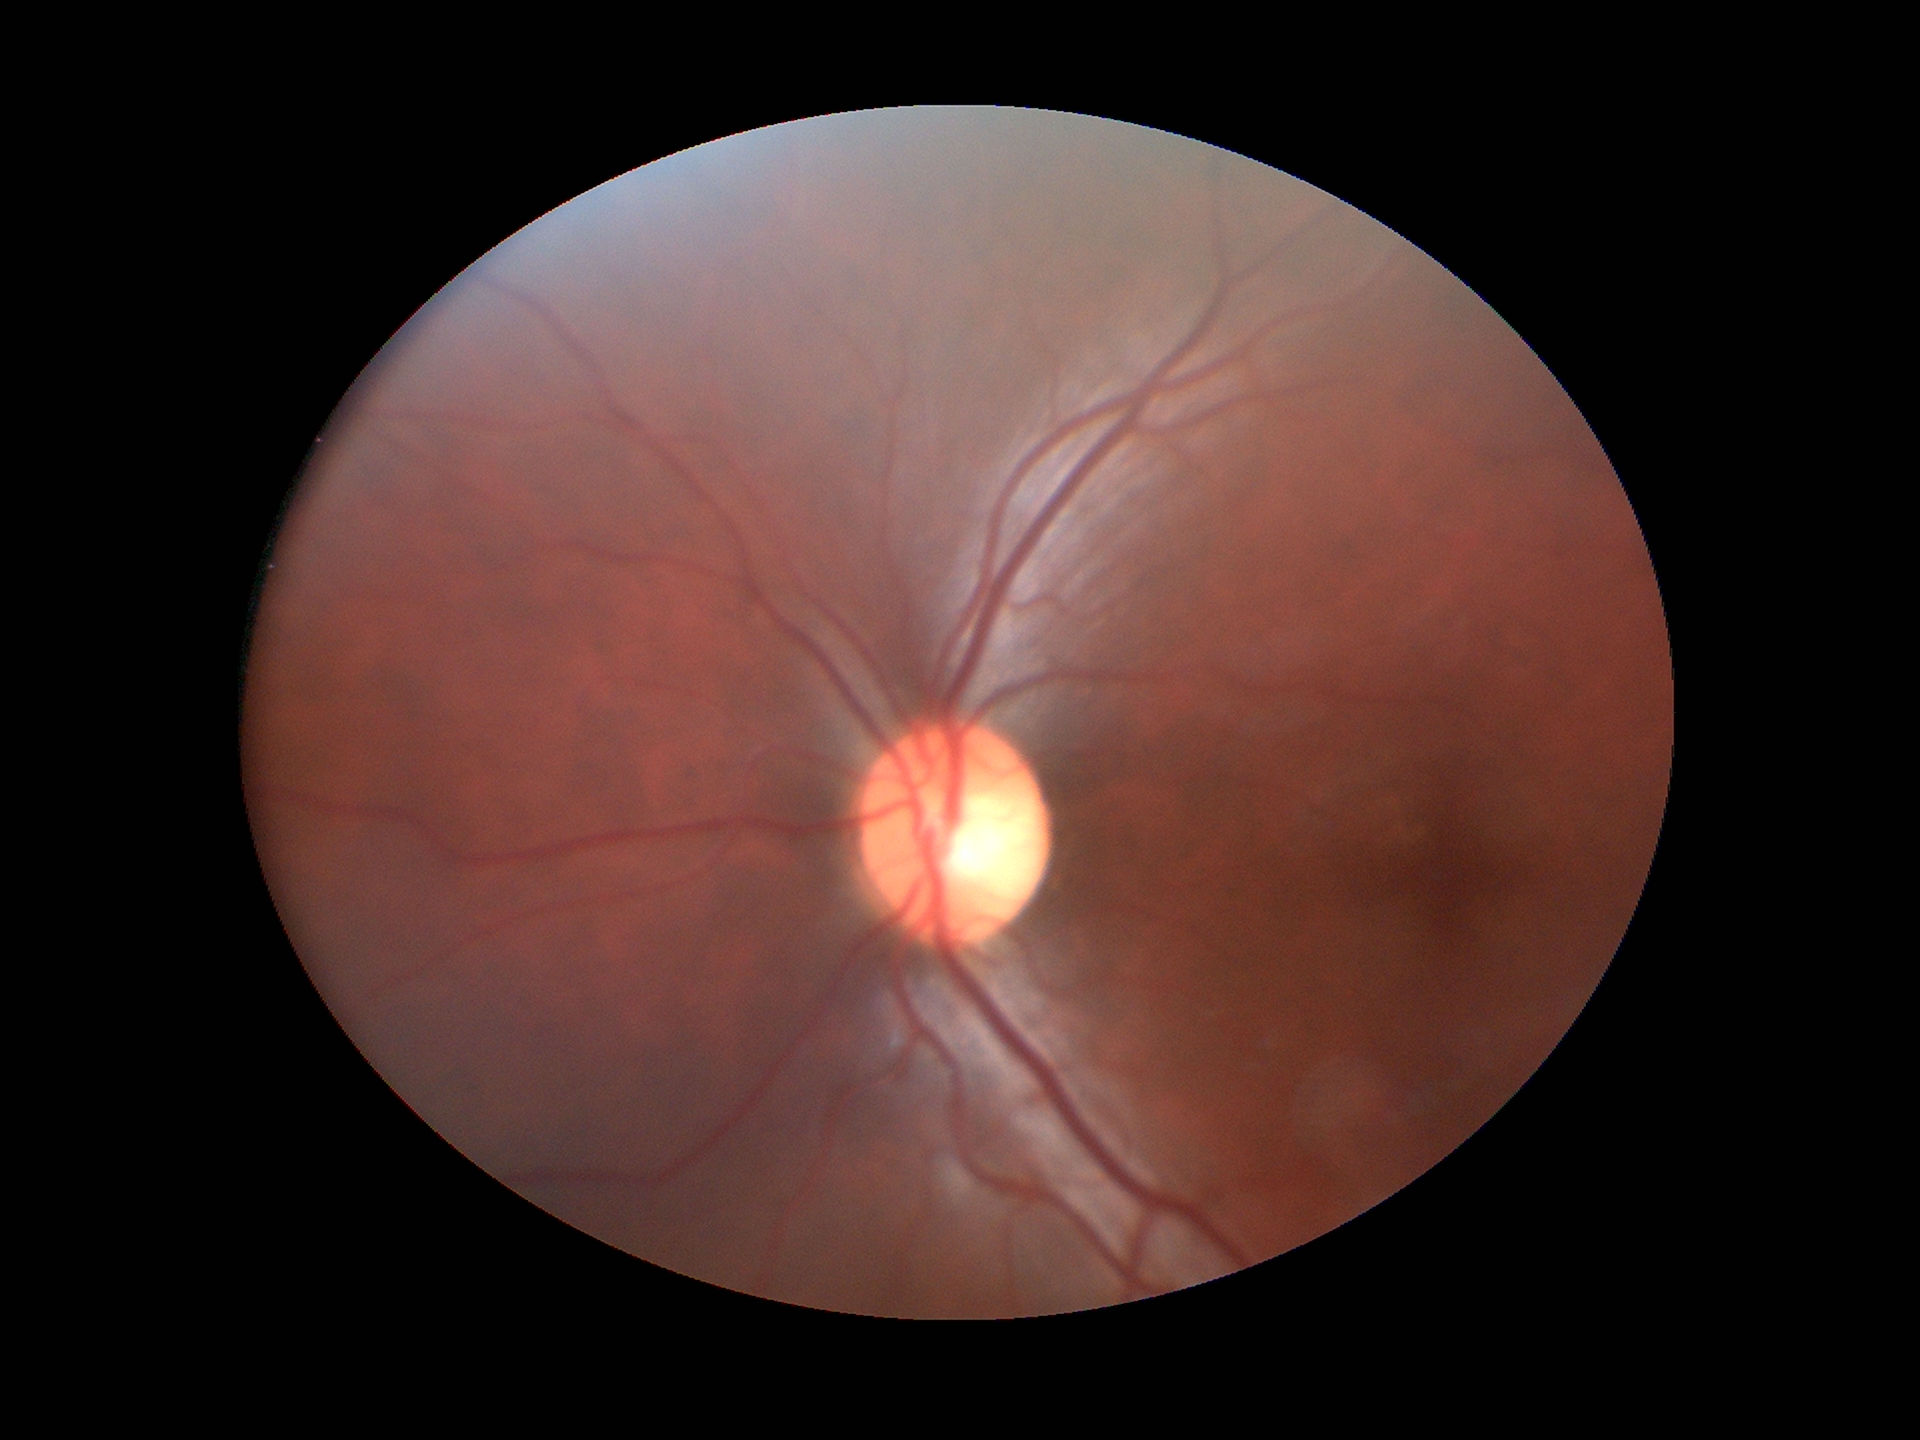 No signs of glaucoma (1 of 5 graders flagged glaucoma suspect). ACDR is 0.30. VCDR: 0.56.